2352x1568, 45-degree field of view, fundus photo — 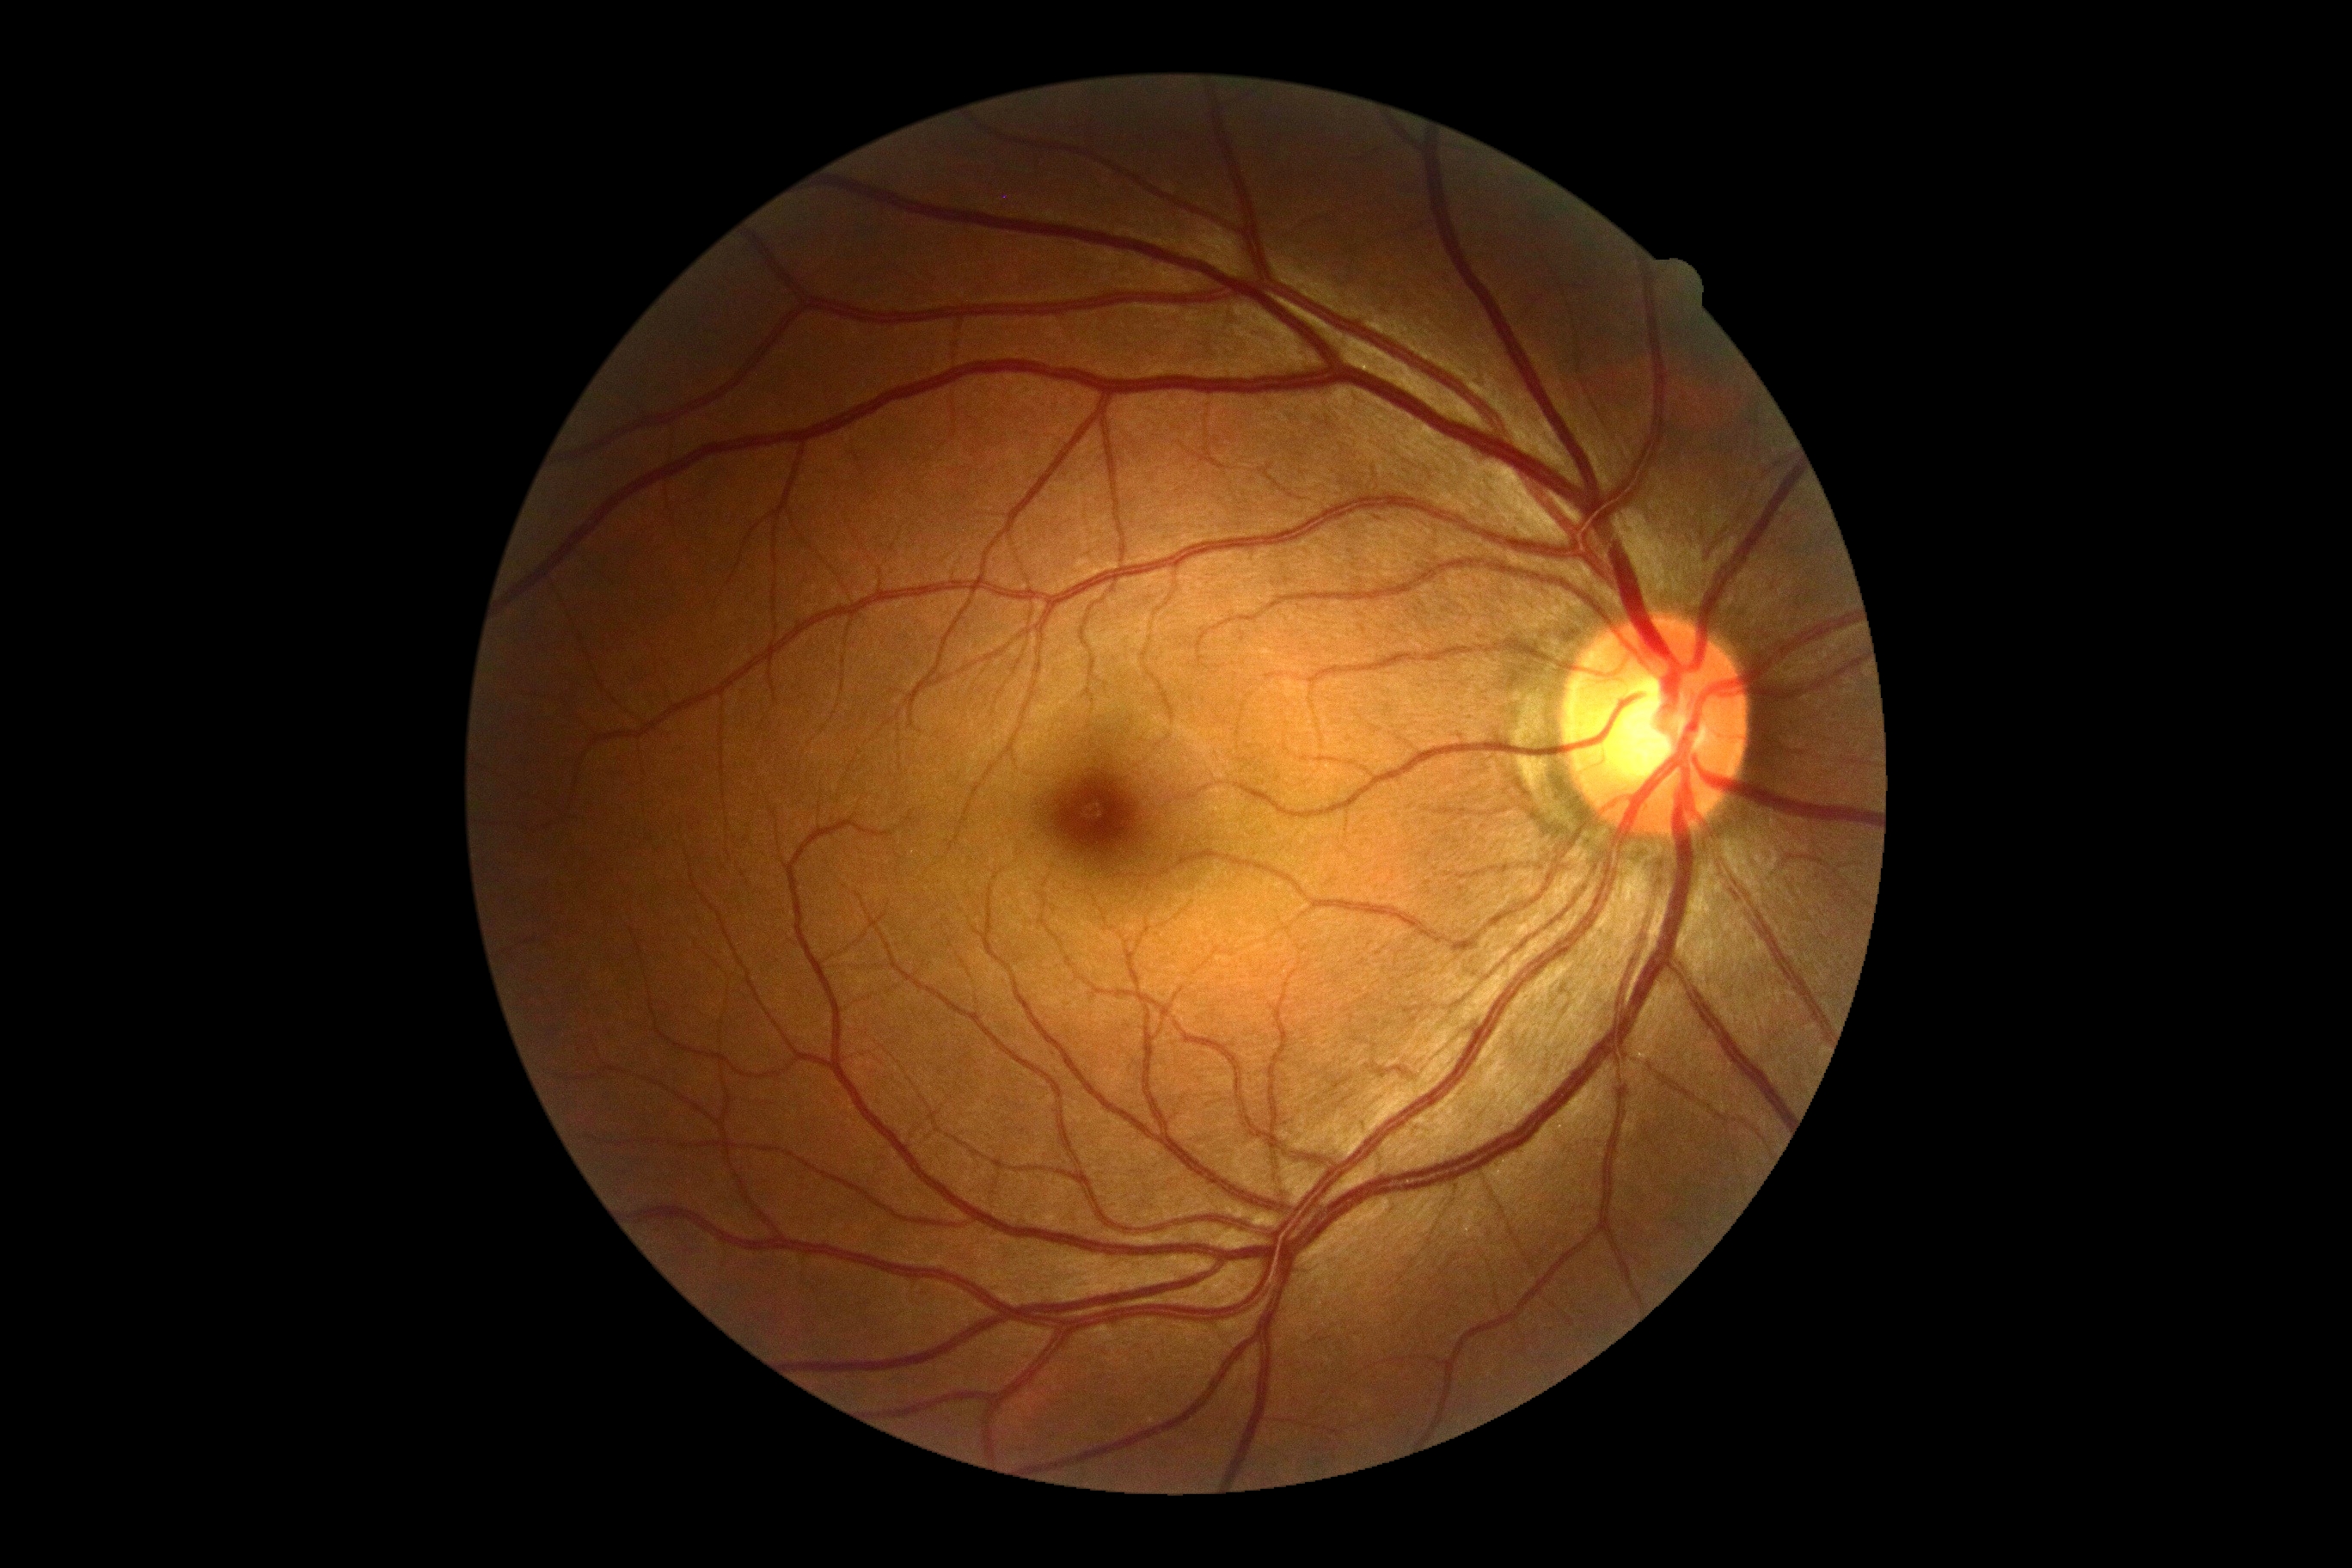

Diabetic retinopathy grade is 0/4.